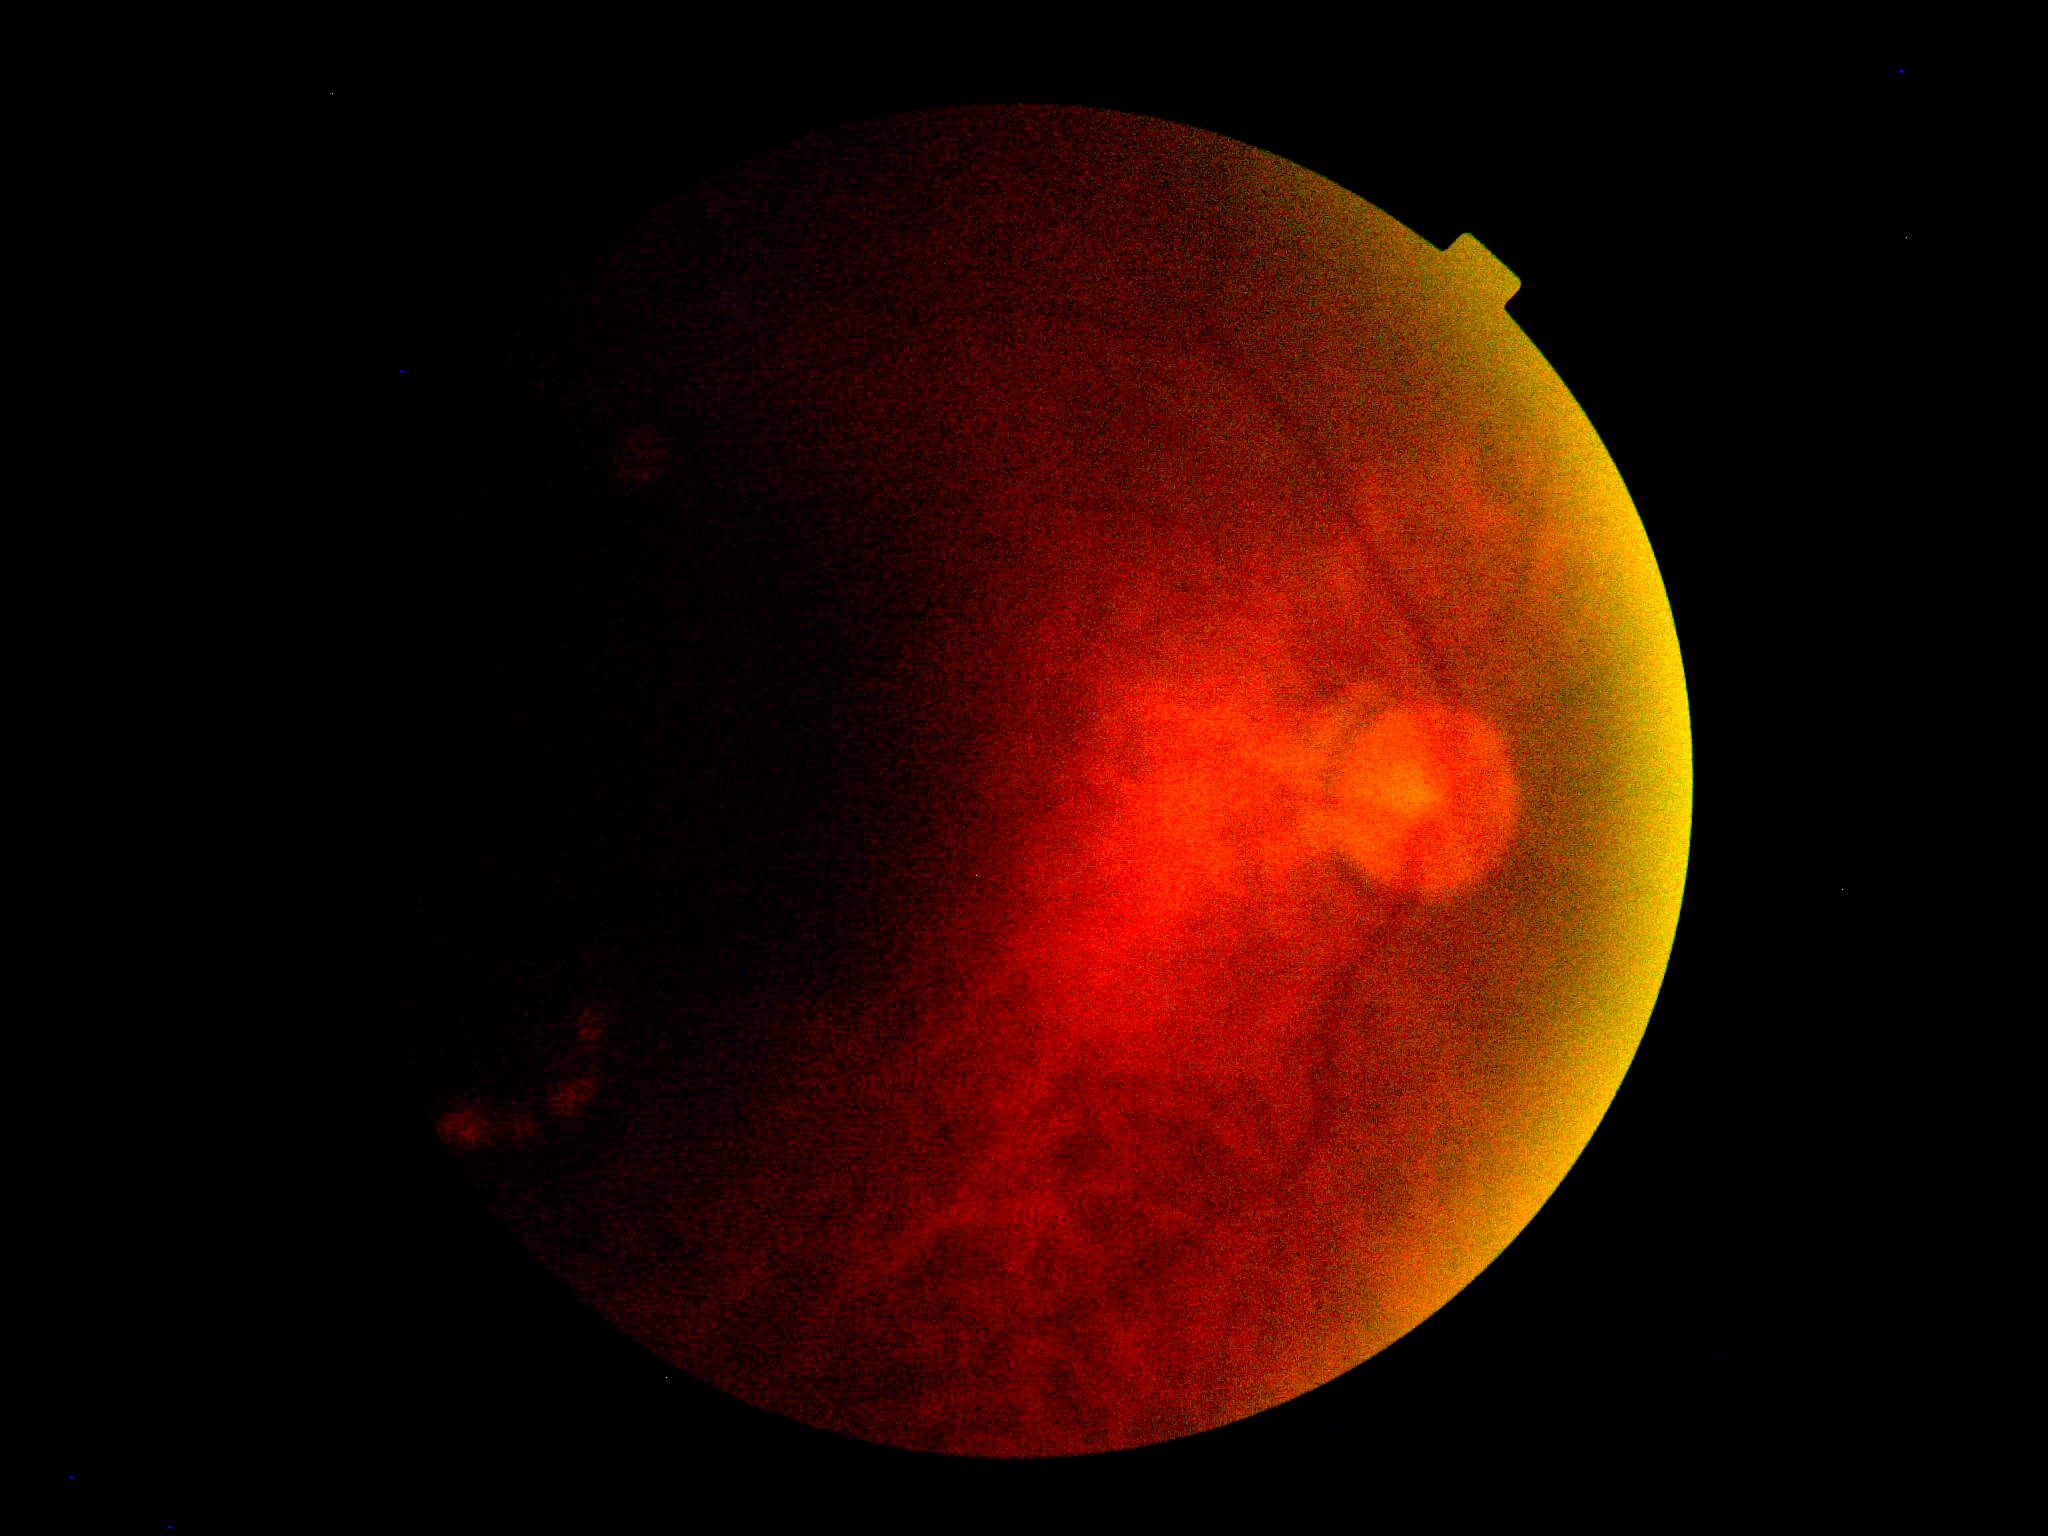
Findings:
– DR: ungradable due to poor image quality
– image quality: insufficient